Retinal fundus photograph; image size 1932x1916; 45° FOV.
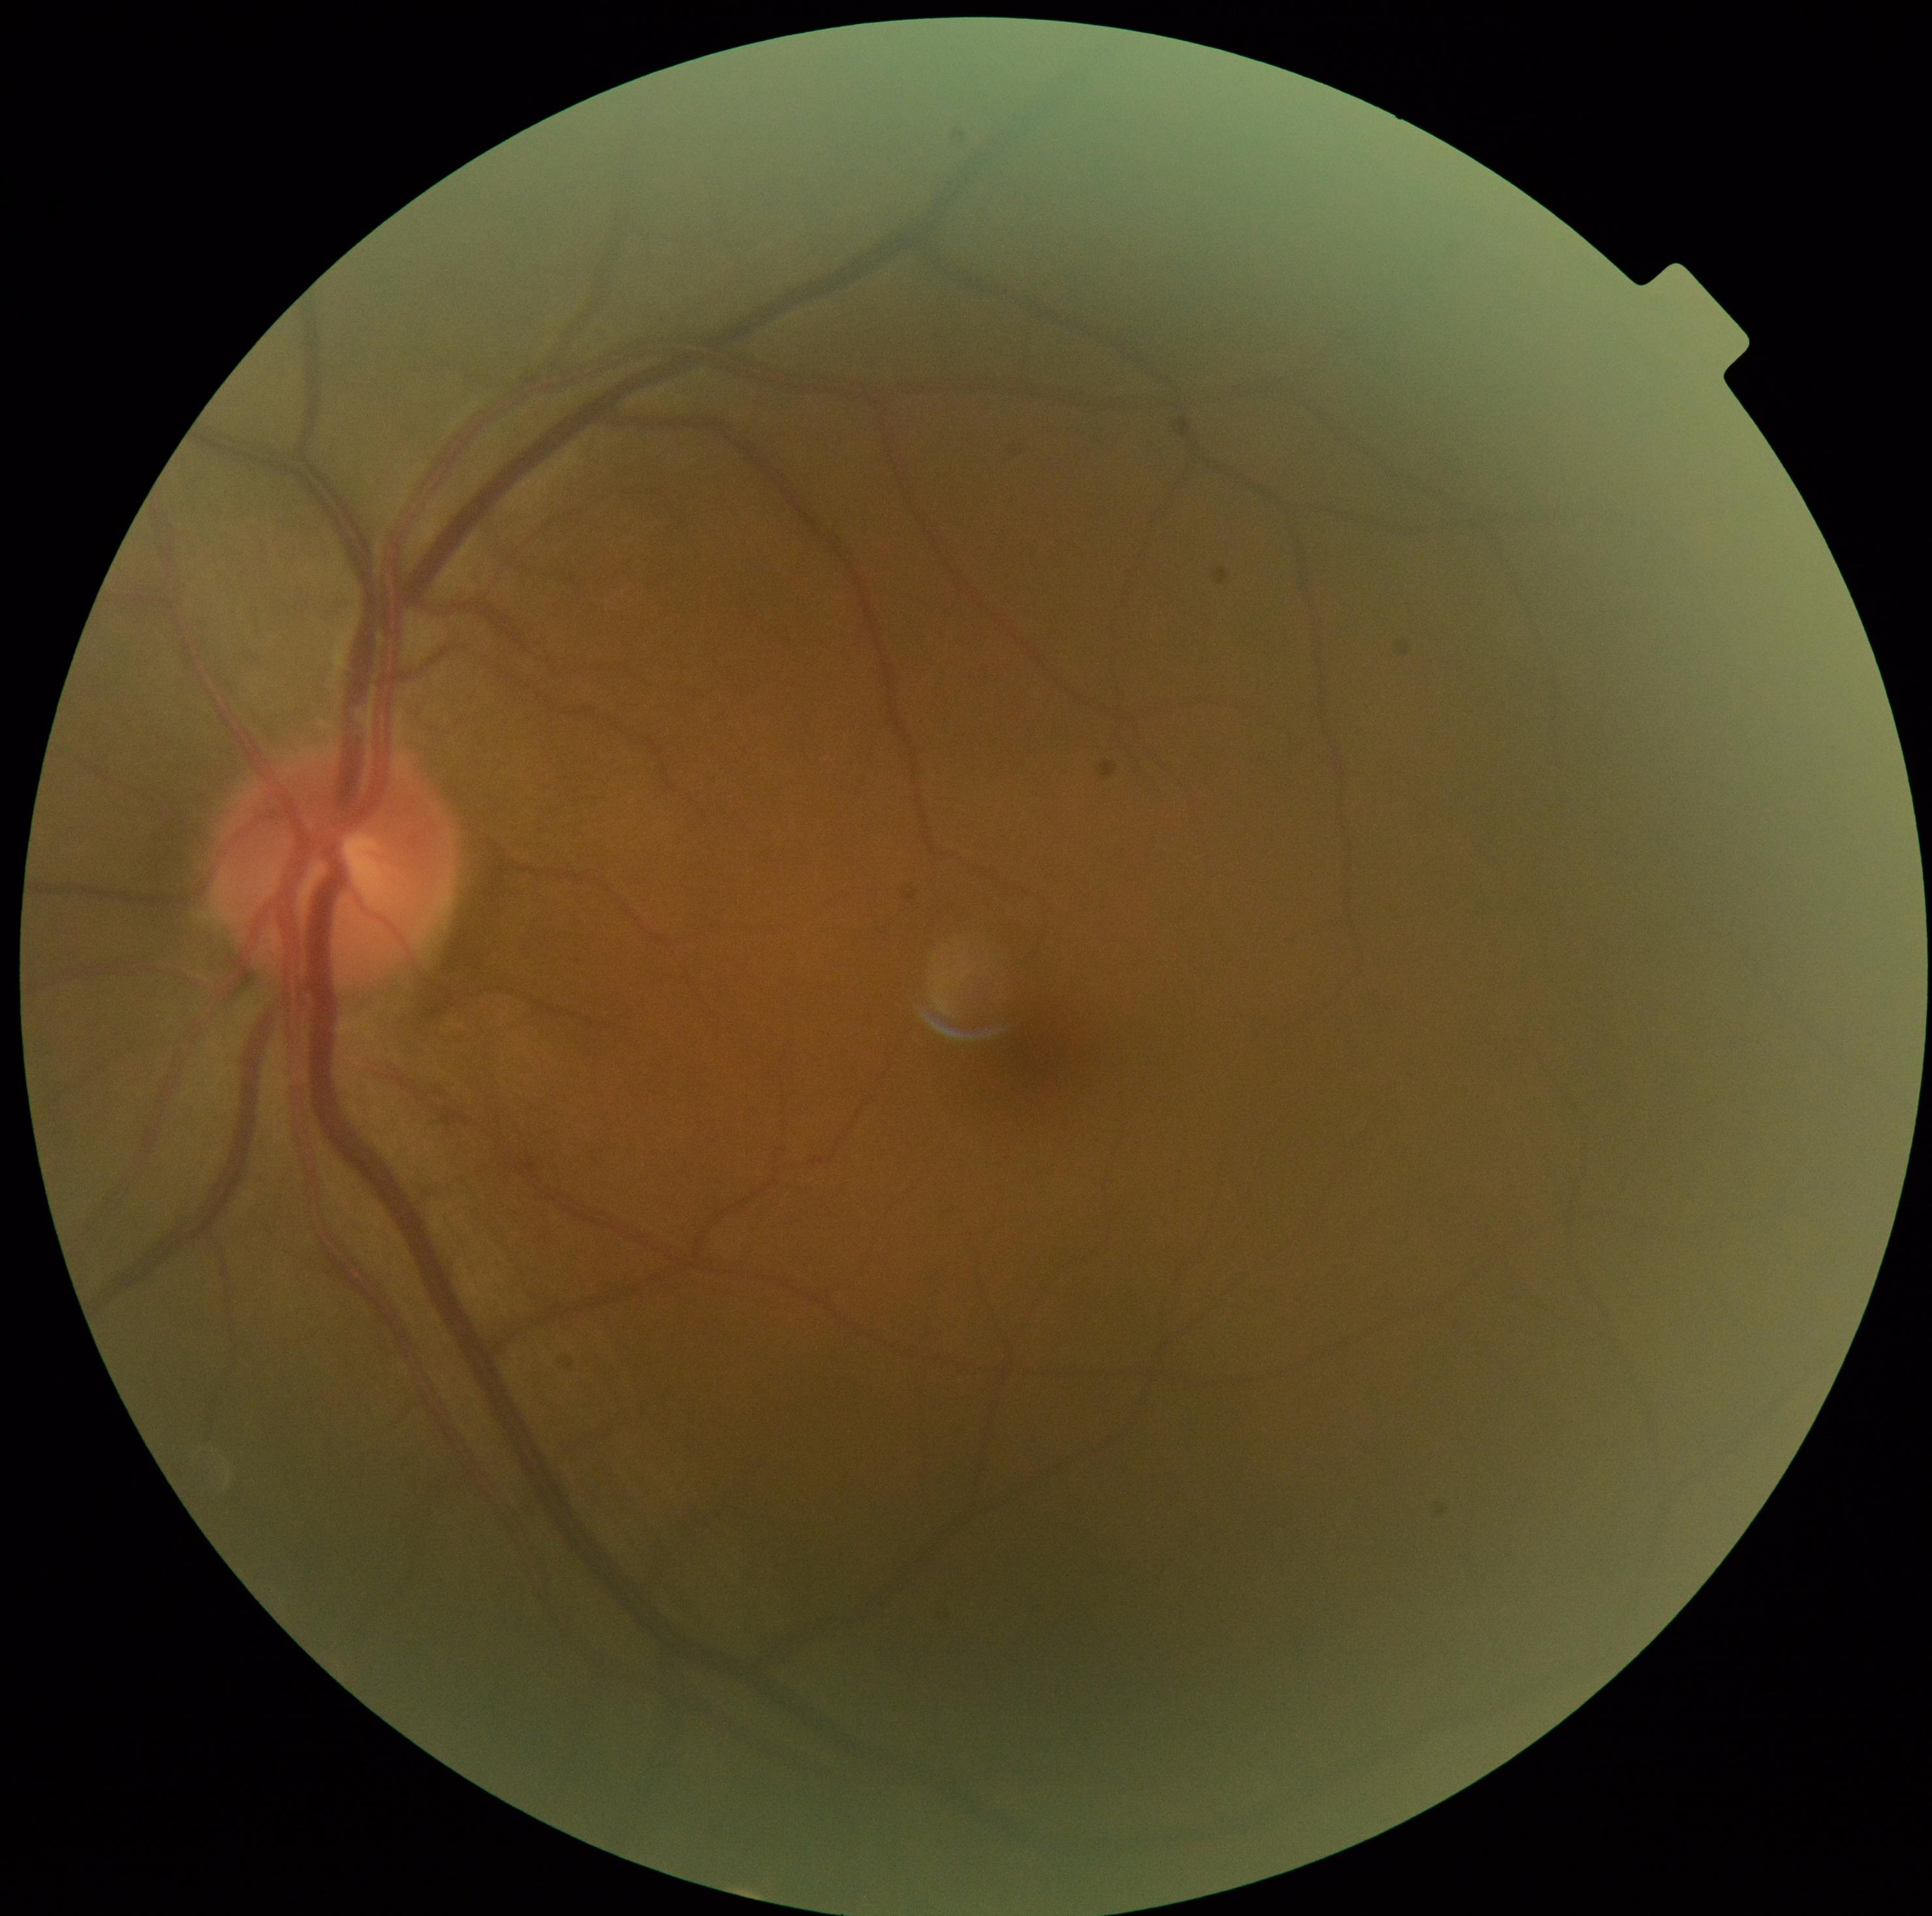

Diabetic retinopathy grade is 0/4.